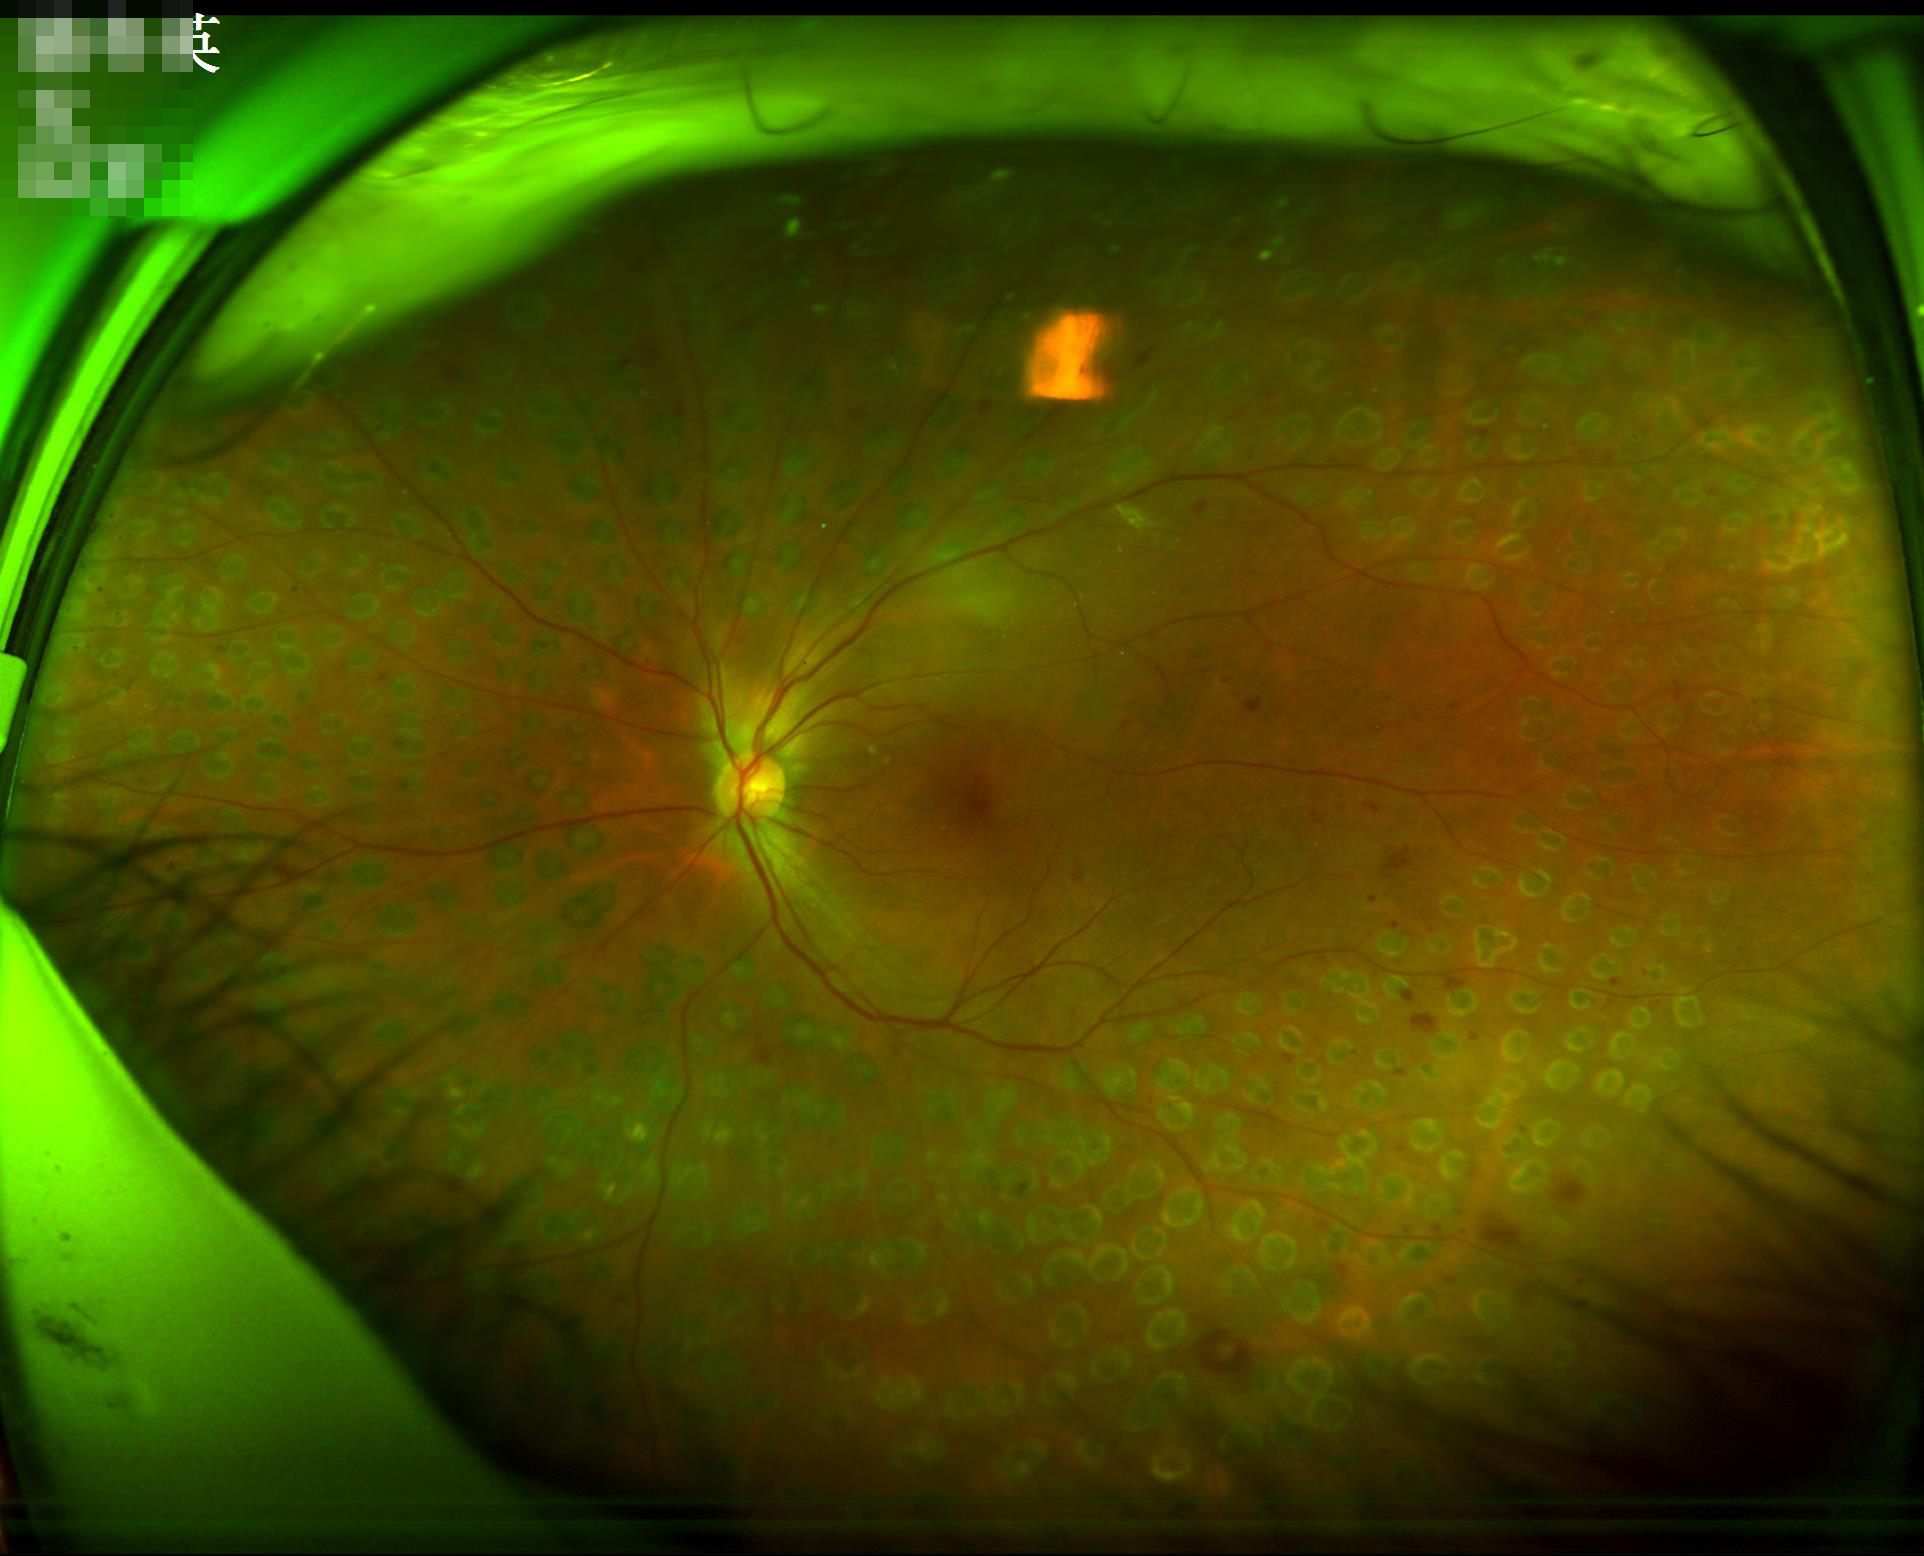 Image quality: focus: blurry | illumination/color: uneven.